Without pupil dilation — 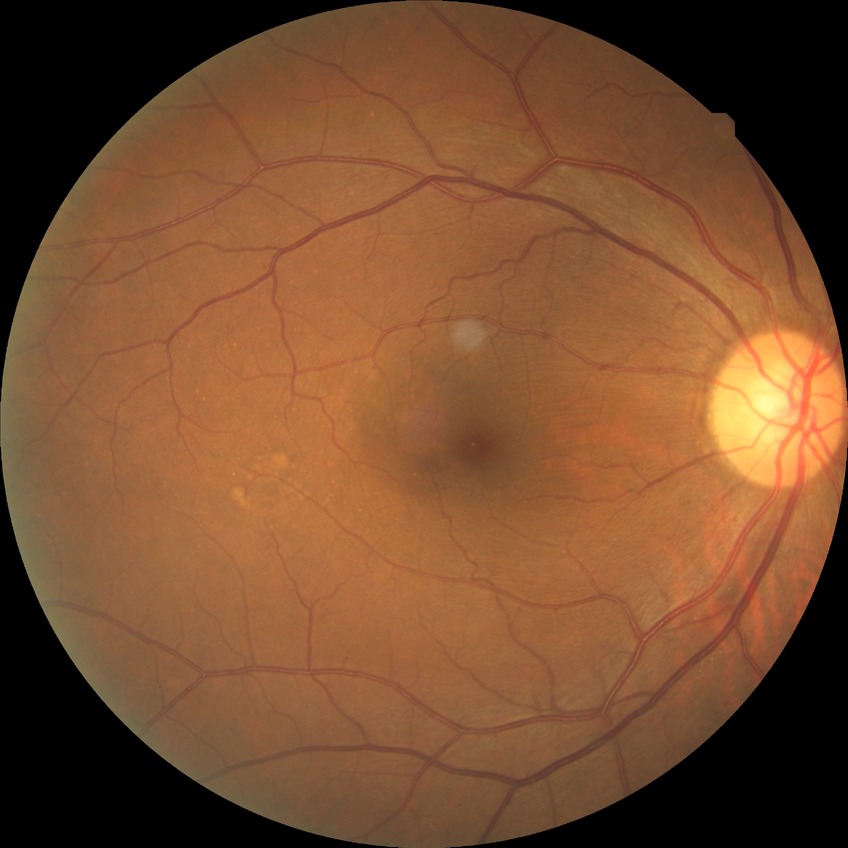 Diabetic retinopathy (DR): NDR (no diabetic retinopathy).